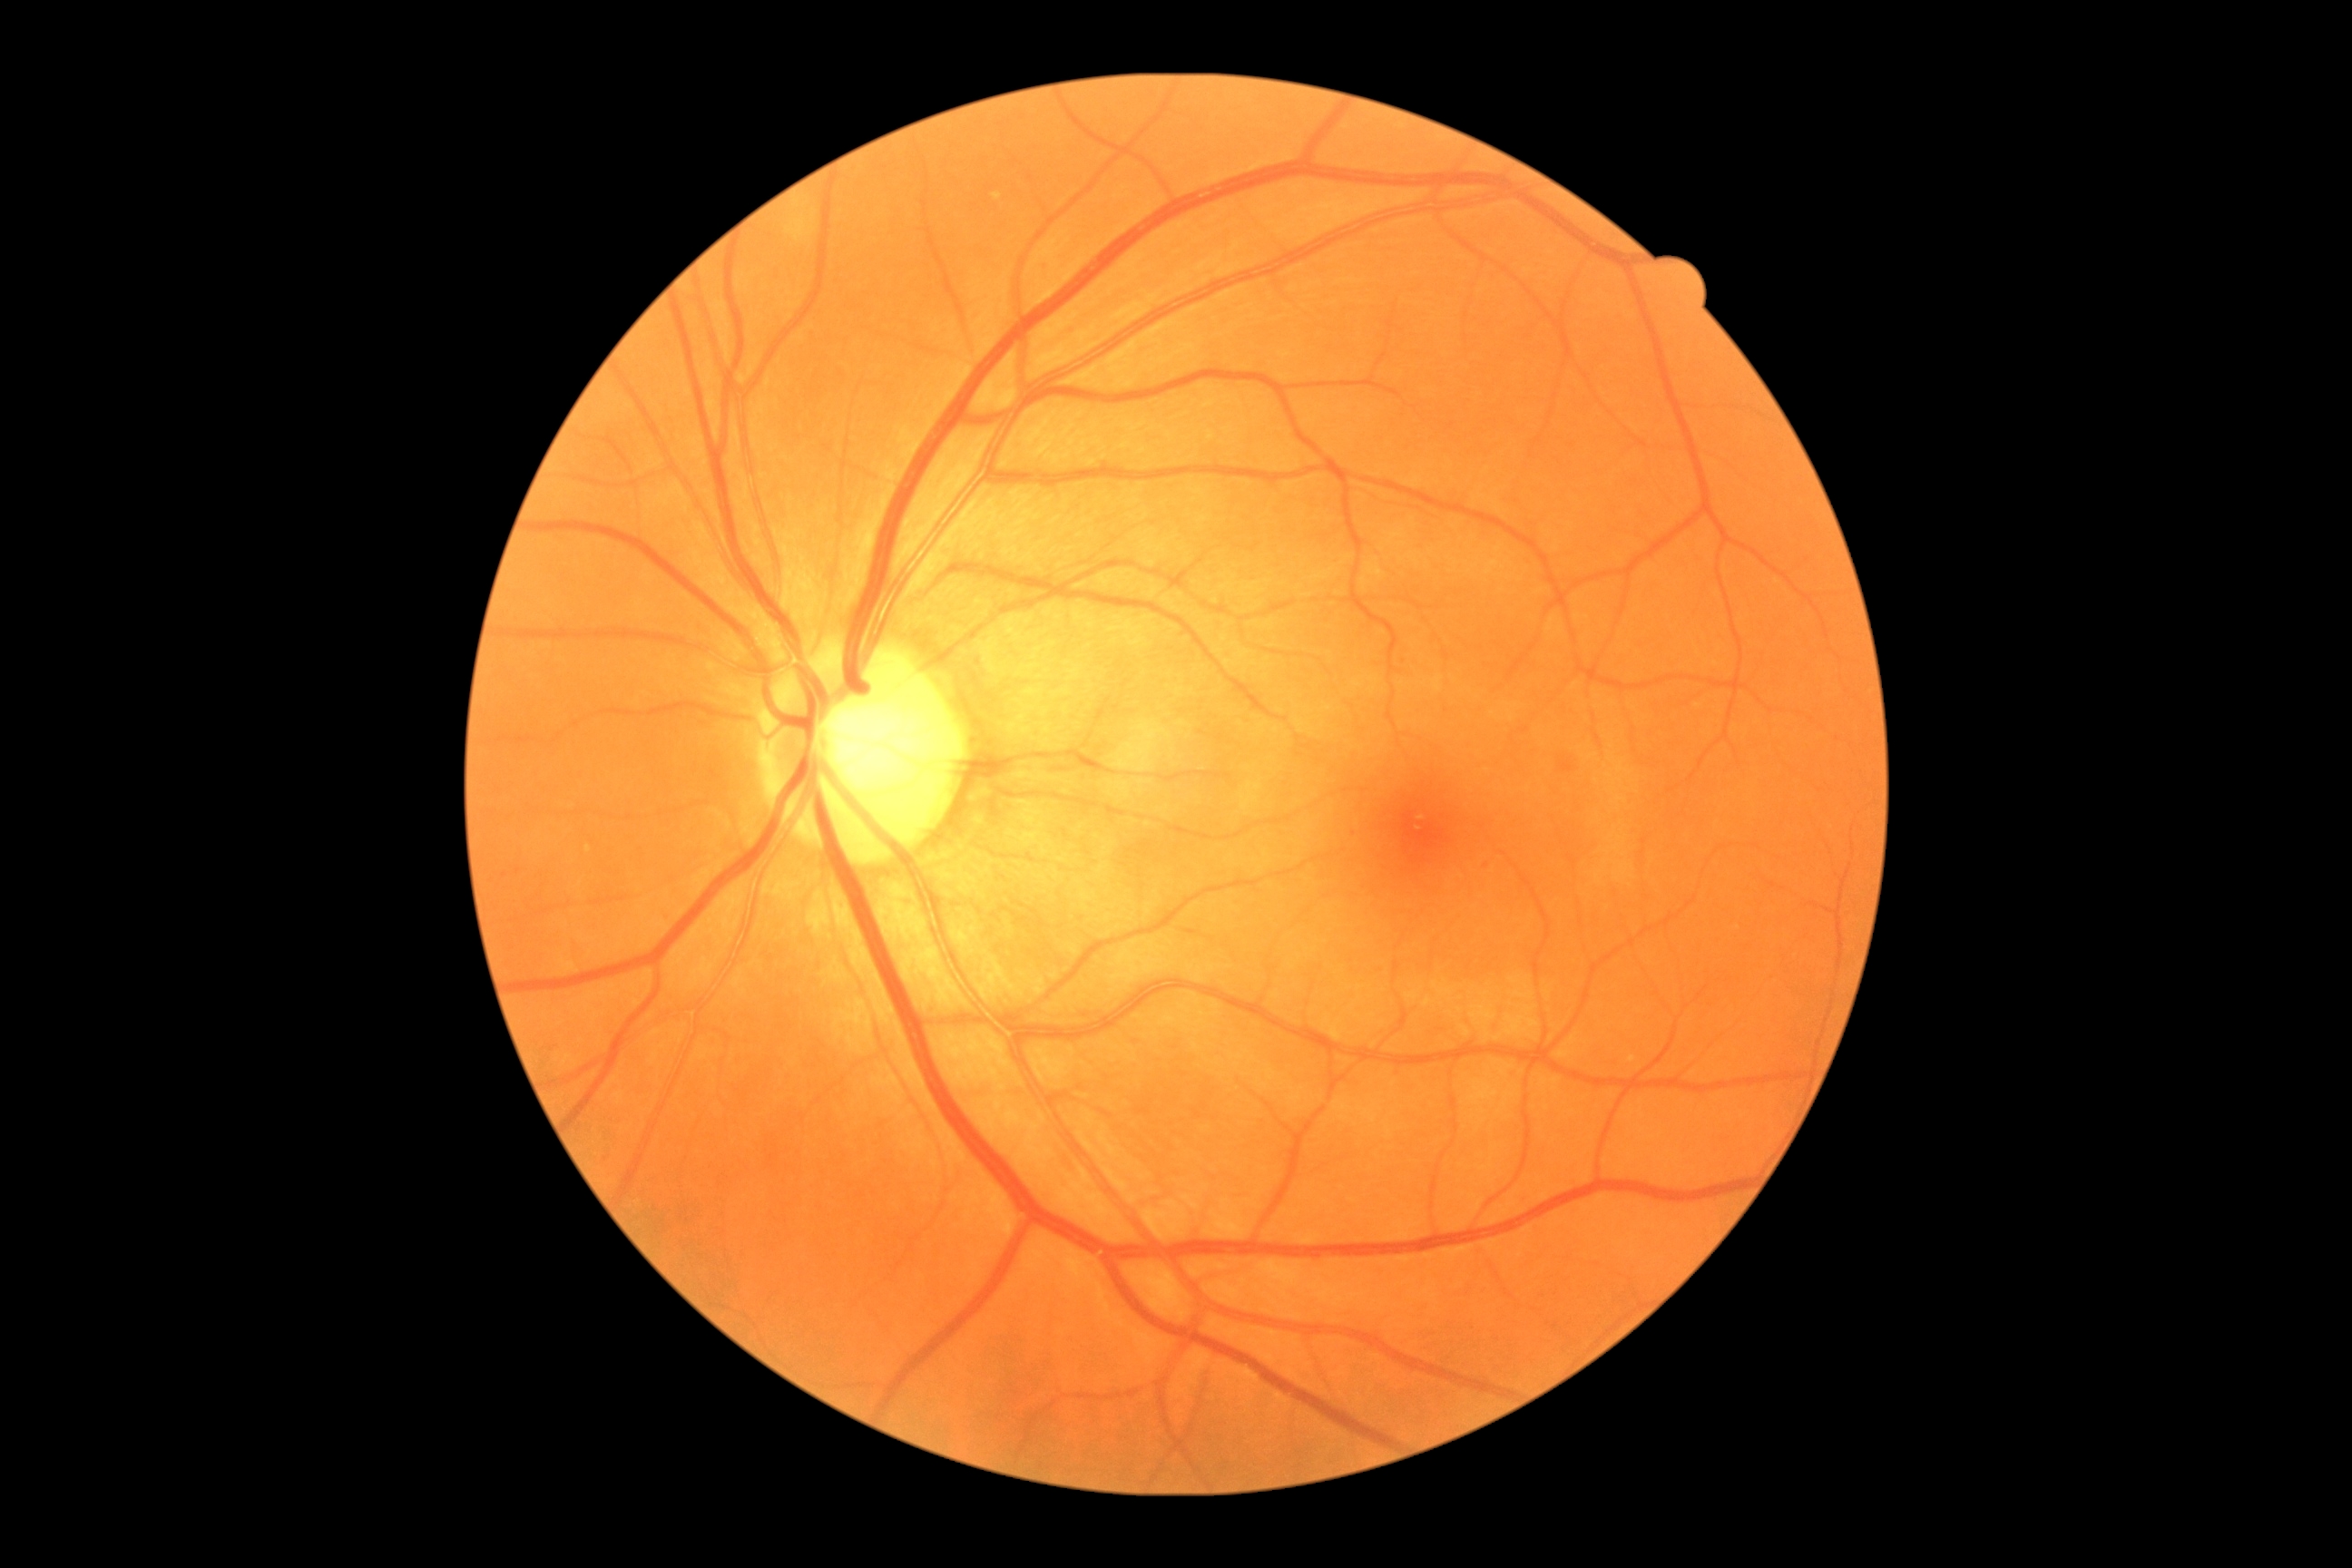
No signs of diabetic retinopathy. Diabetic retinopathy (DR) is 0/4.